Without pupil dilation · modified Davis classification.
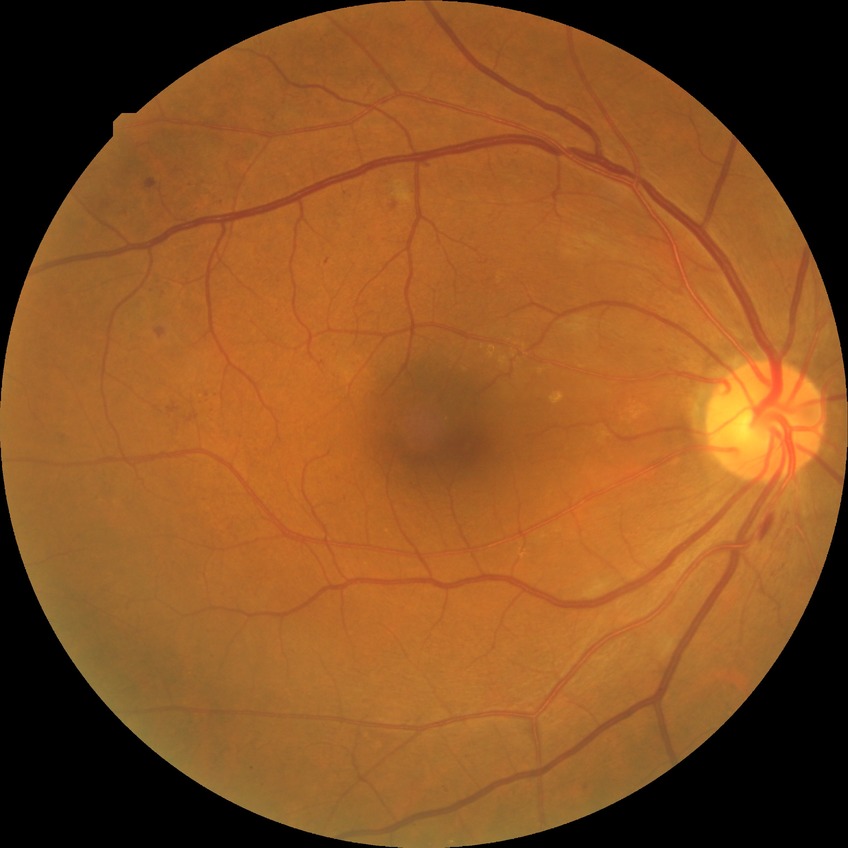
modified Davis classification = pre-proliferative diabetic retinopathy.